45-degree field of view · color fundus image:
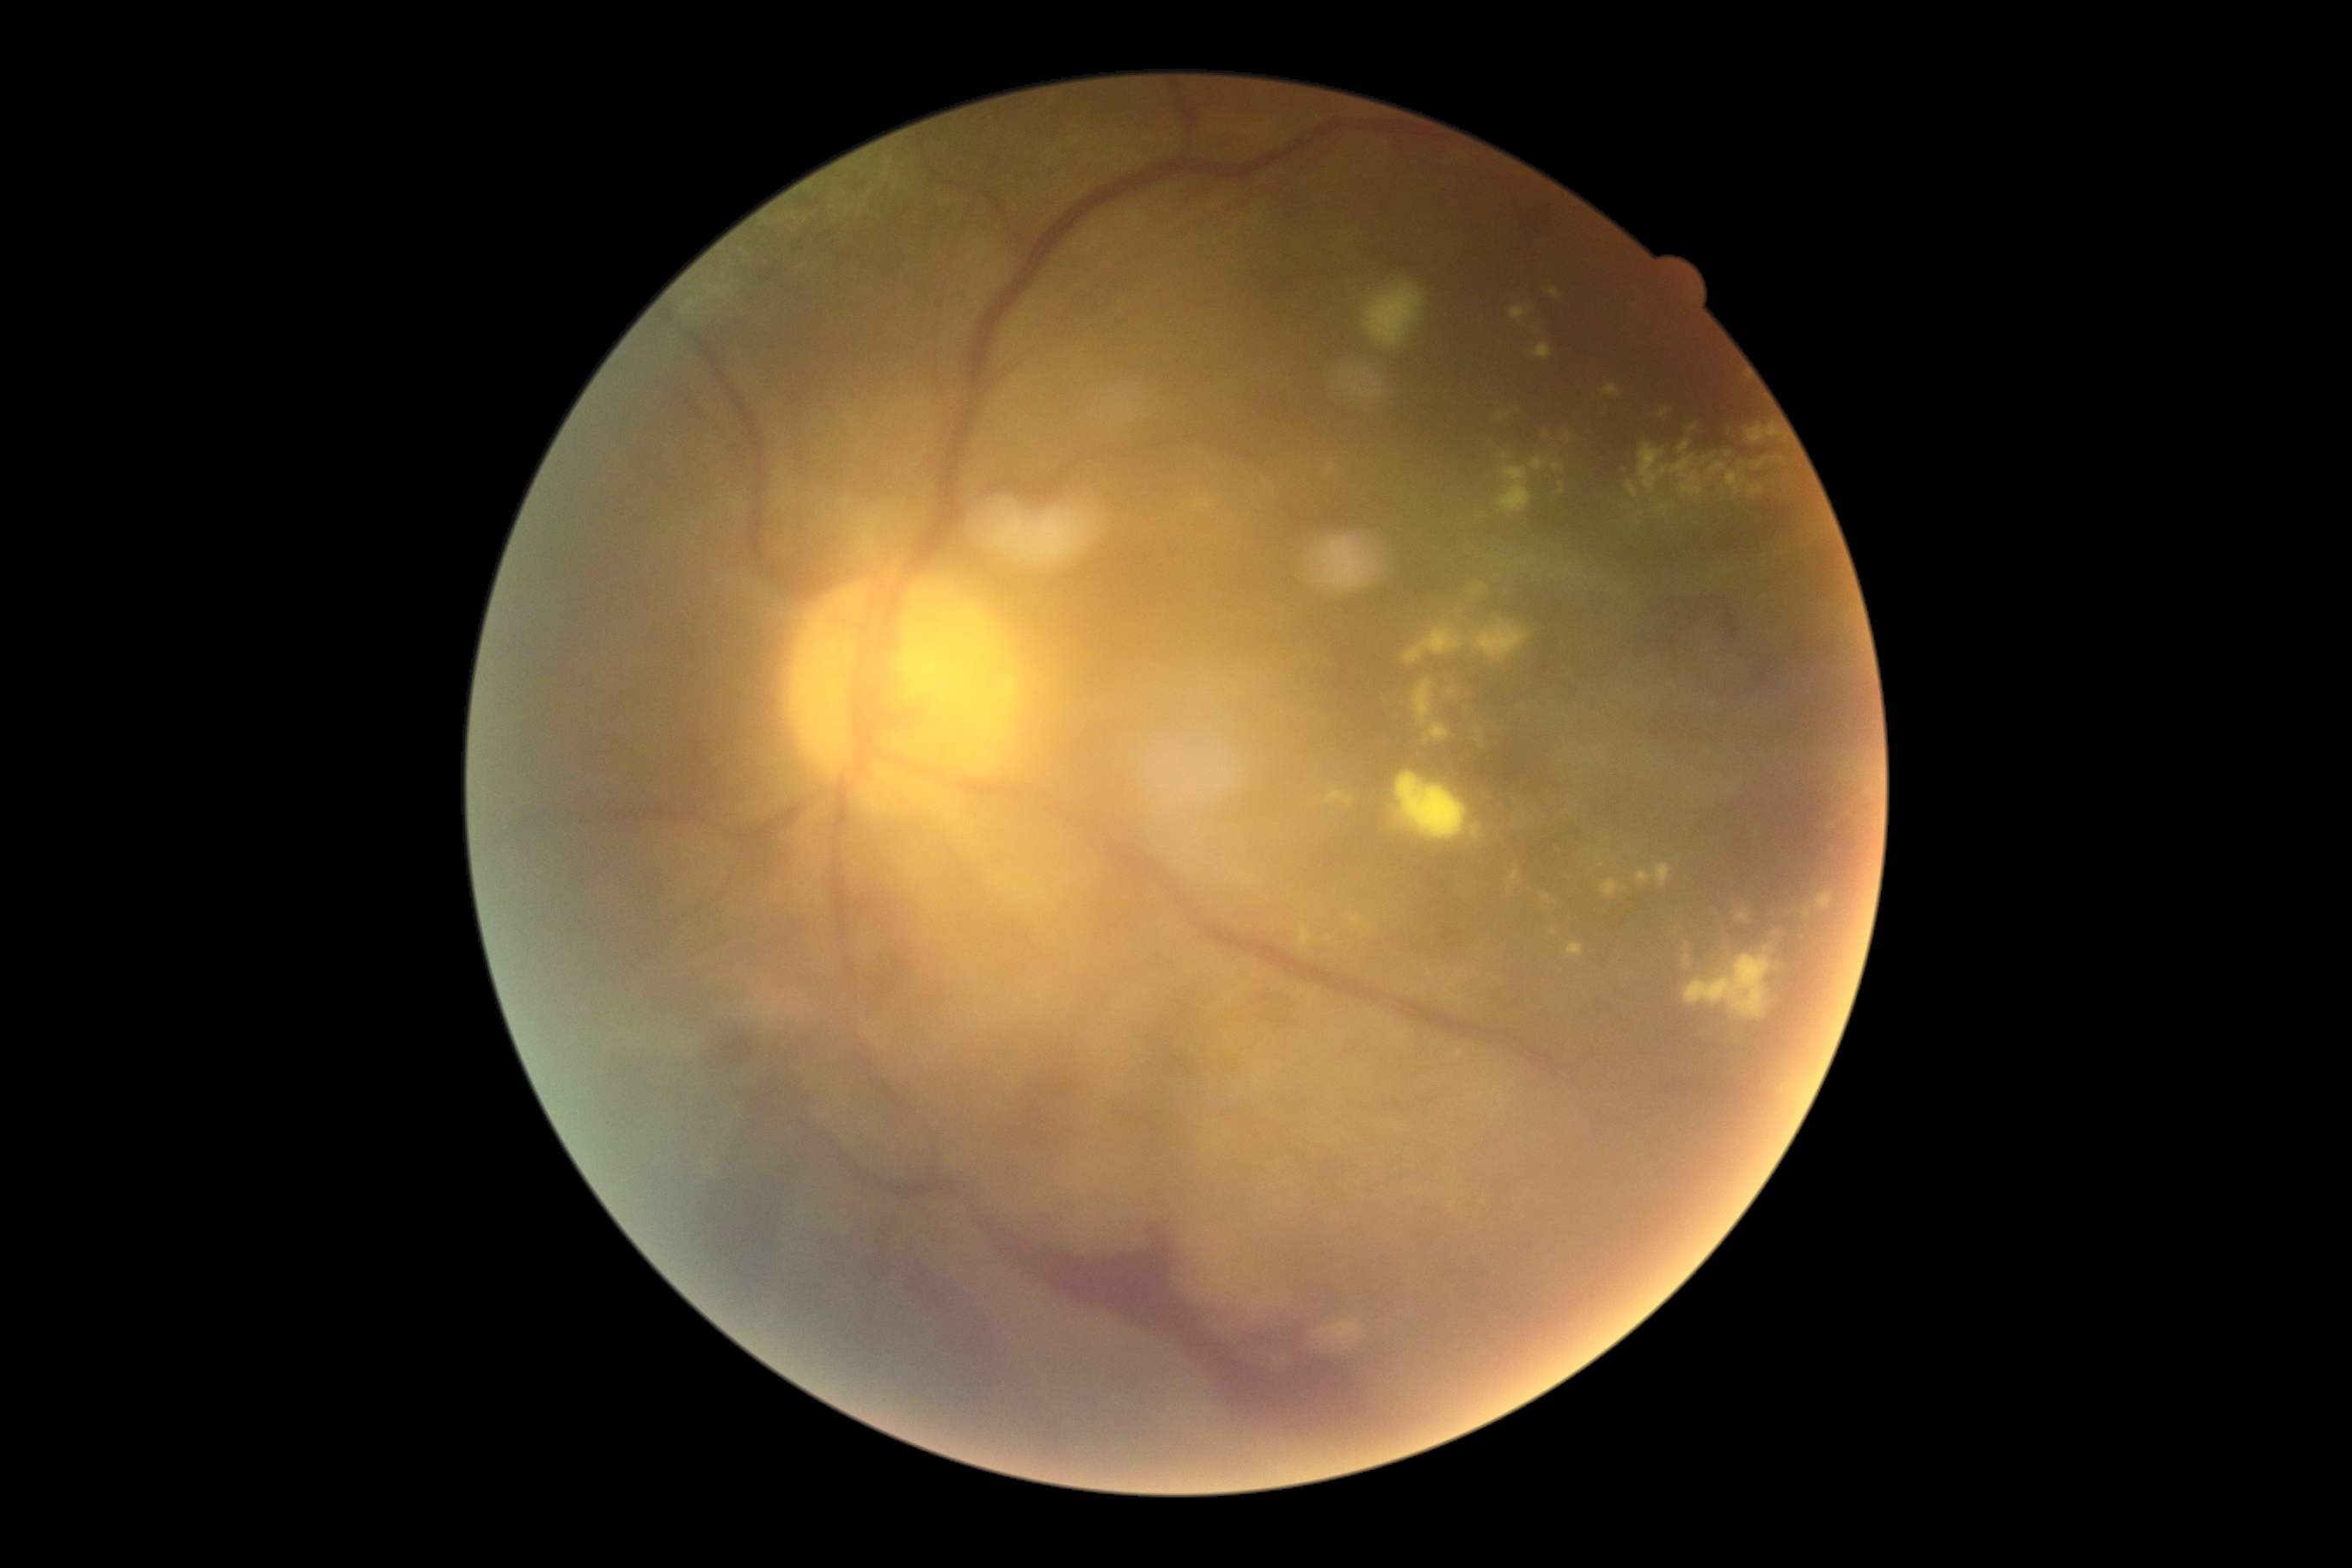

Retinopathy grade: PDR (4)
A subset of detected lesions:
hard exudates (subset): x1=1658 y1=408 x2=1670 y2=419; x1=1816 y1=893 x2=1832 y2=910; x1=1804 y1=909 x2=1813 y2=917; x1=1541 y1=893 x2=1555 y2=905; x1=1655 y1=864 x2=1672 y2=888; x1=1746 y1=424 x2=1782 y2=444; x1=1736 y1=909 x2=1749 y2=922; x1=1559 y1=482 x2=1565 y2=496; x1=1712 y1=572 x2=1717 y2=580; x1=1349 y1=914 x2=1364 y2=928; x1=1411 y1=680 x2=1450 y2=745
Small hard exudates near [1507,456]; [1553,933]; [1464,972]; [1482,516]